1240x1240 · wide-field fundus photograph from neonatal ROP screening:
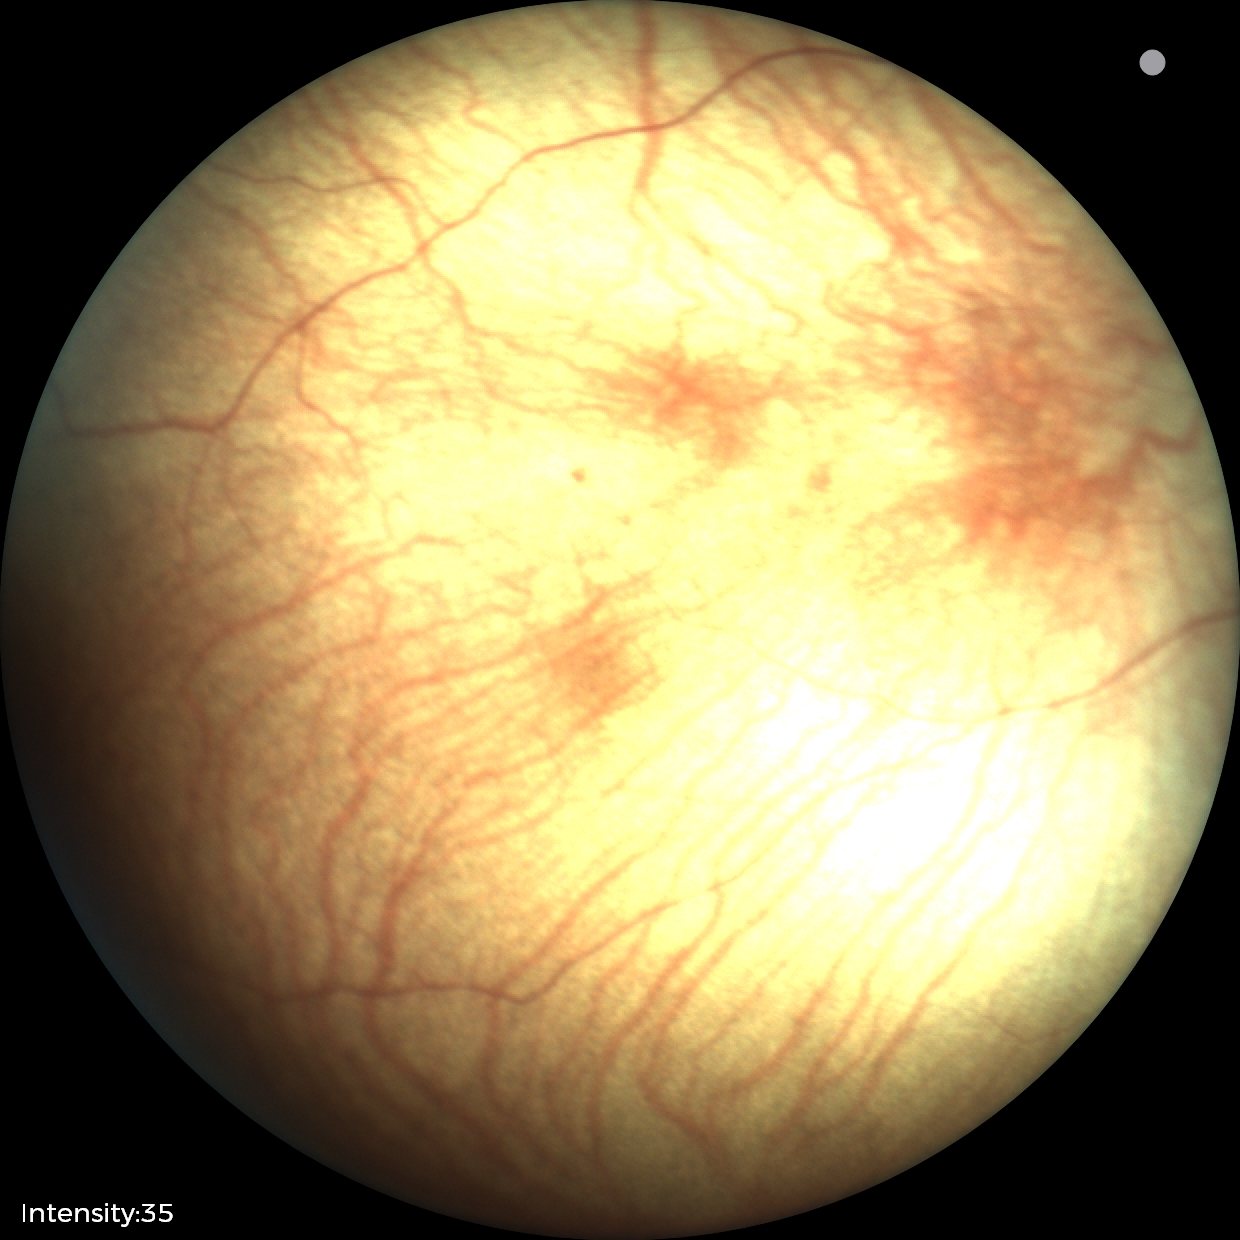
Screening examination diagnosed as physiological.